Wide-field fundus photograph from neonatal ROP screening — 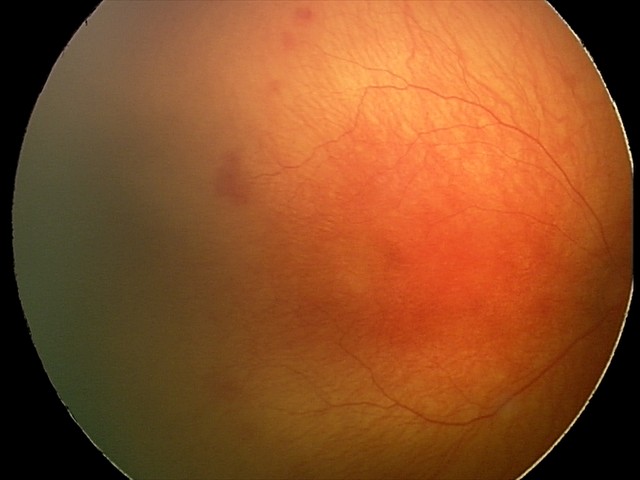 Impression: aggressive retinopathy of prematurity (A-ROP).